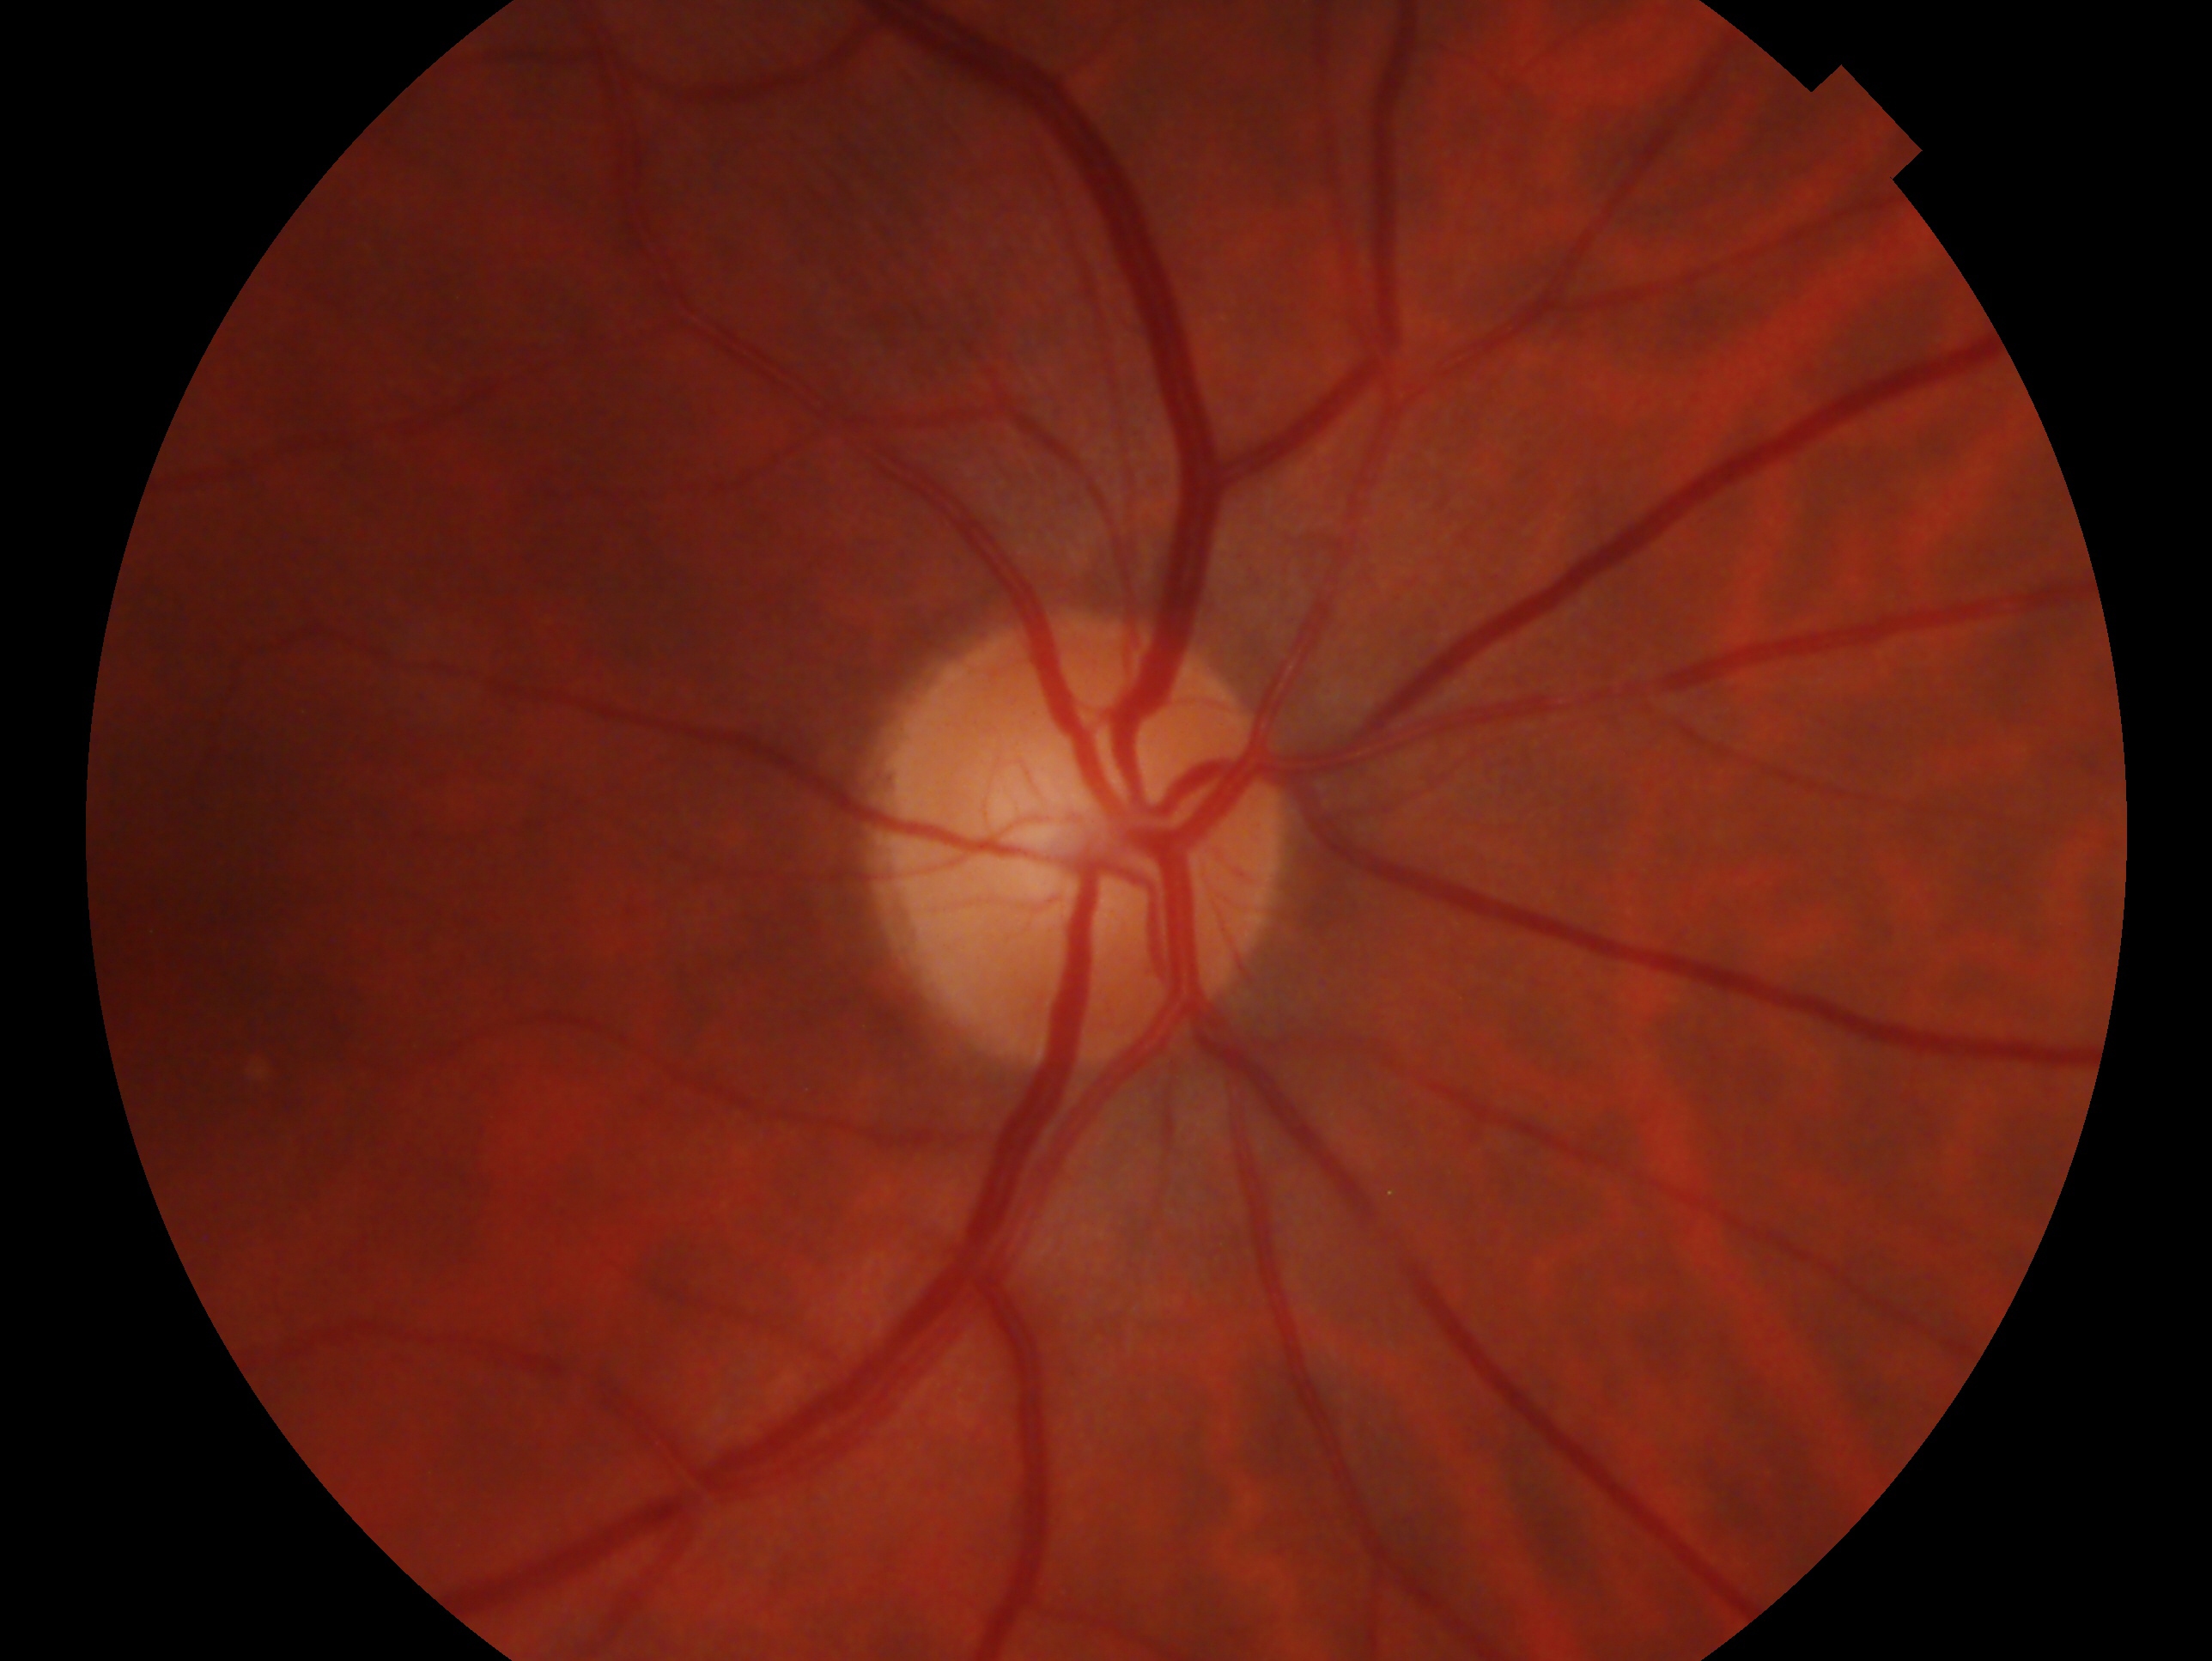

Diagnosis — negative for glaucoma.
This is the right eye.